Infant wide-field fundus photograph. 640 by 480 pixels. Clarity RetCam 3, 130° FOV:
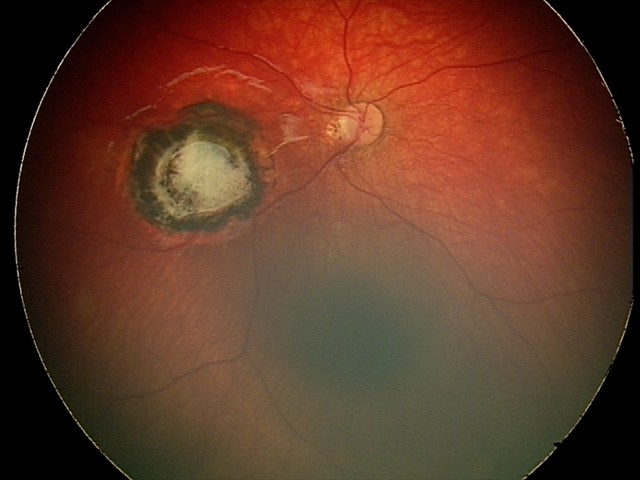

Diagnosis from this screening exam: toxoplasmosis chorioretinitis.